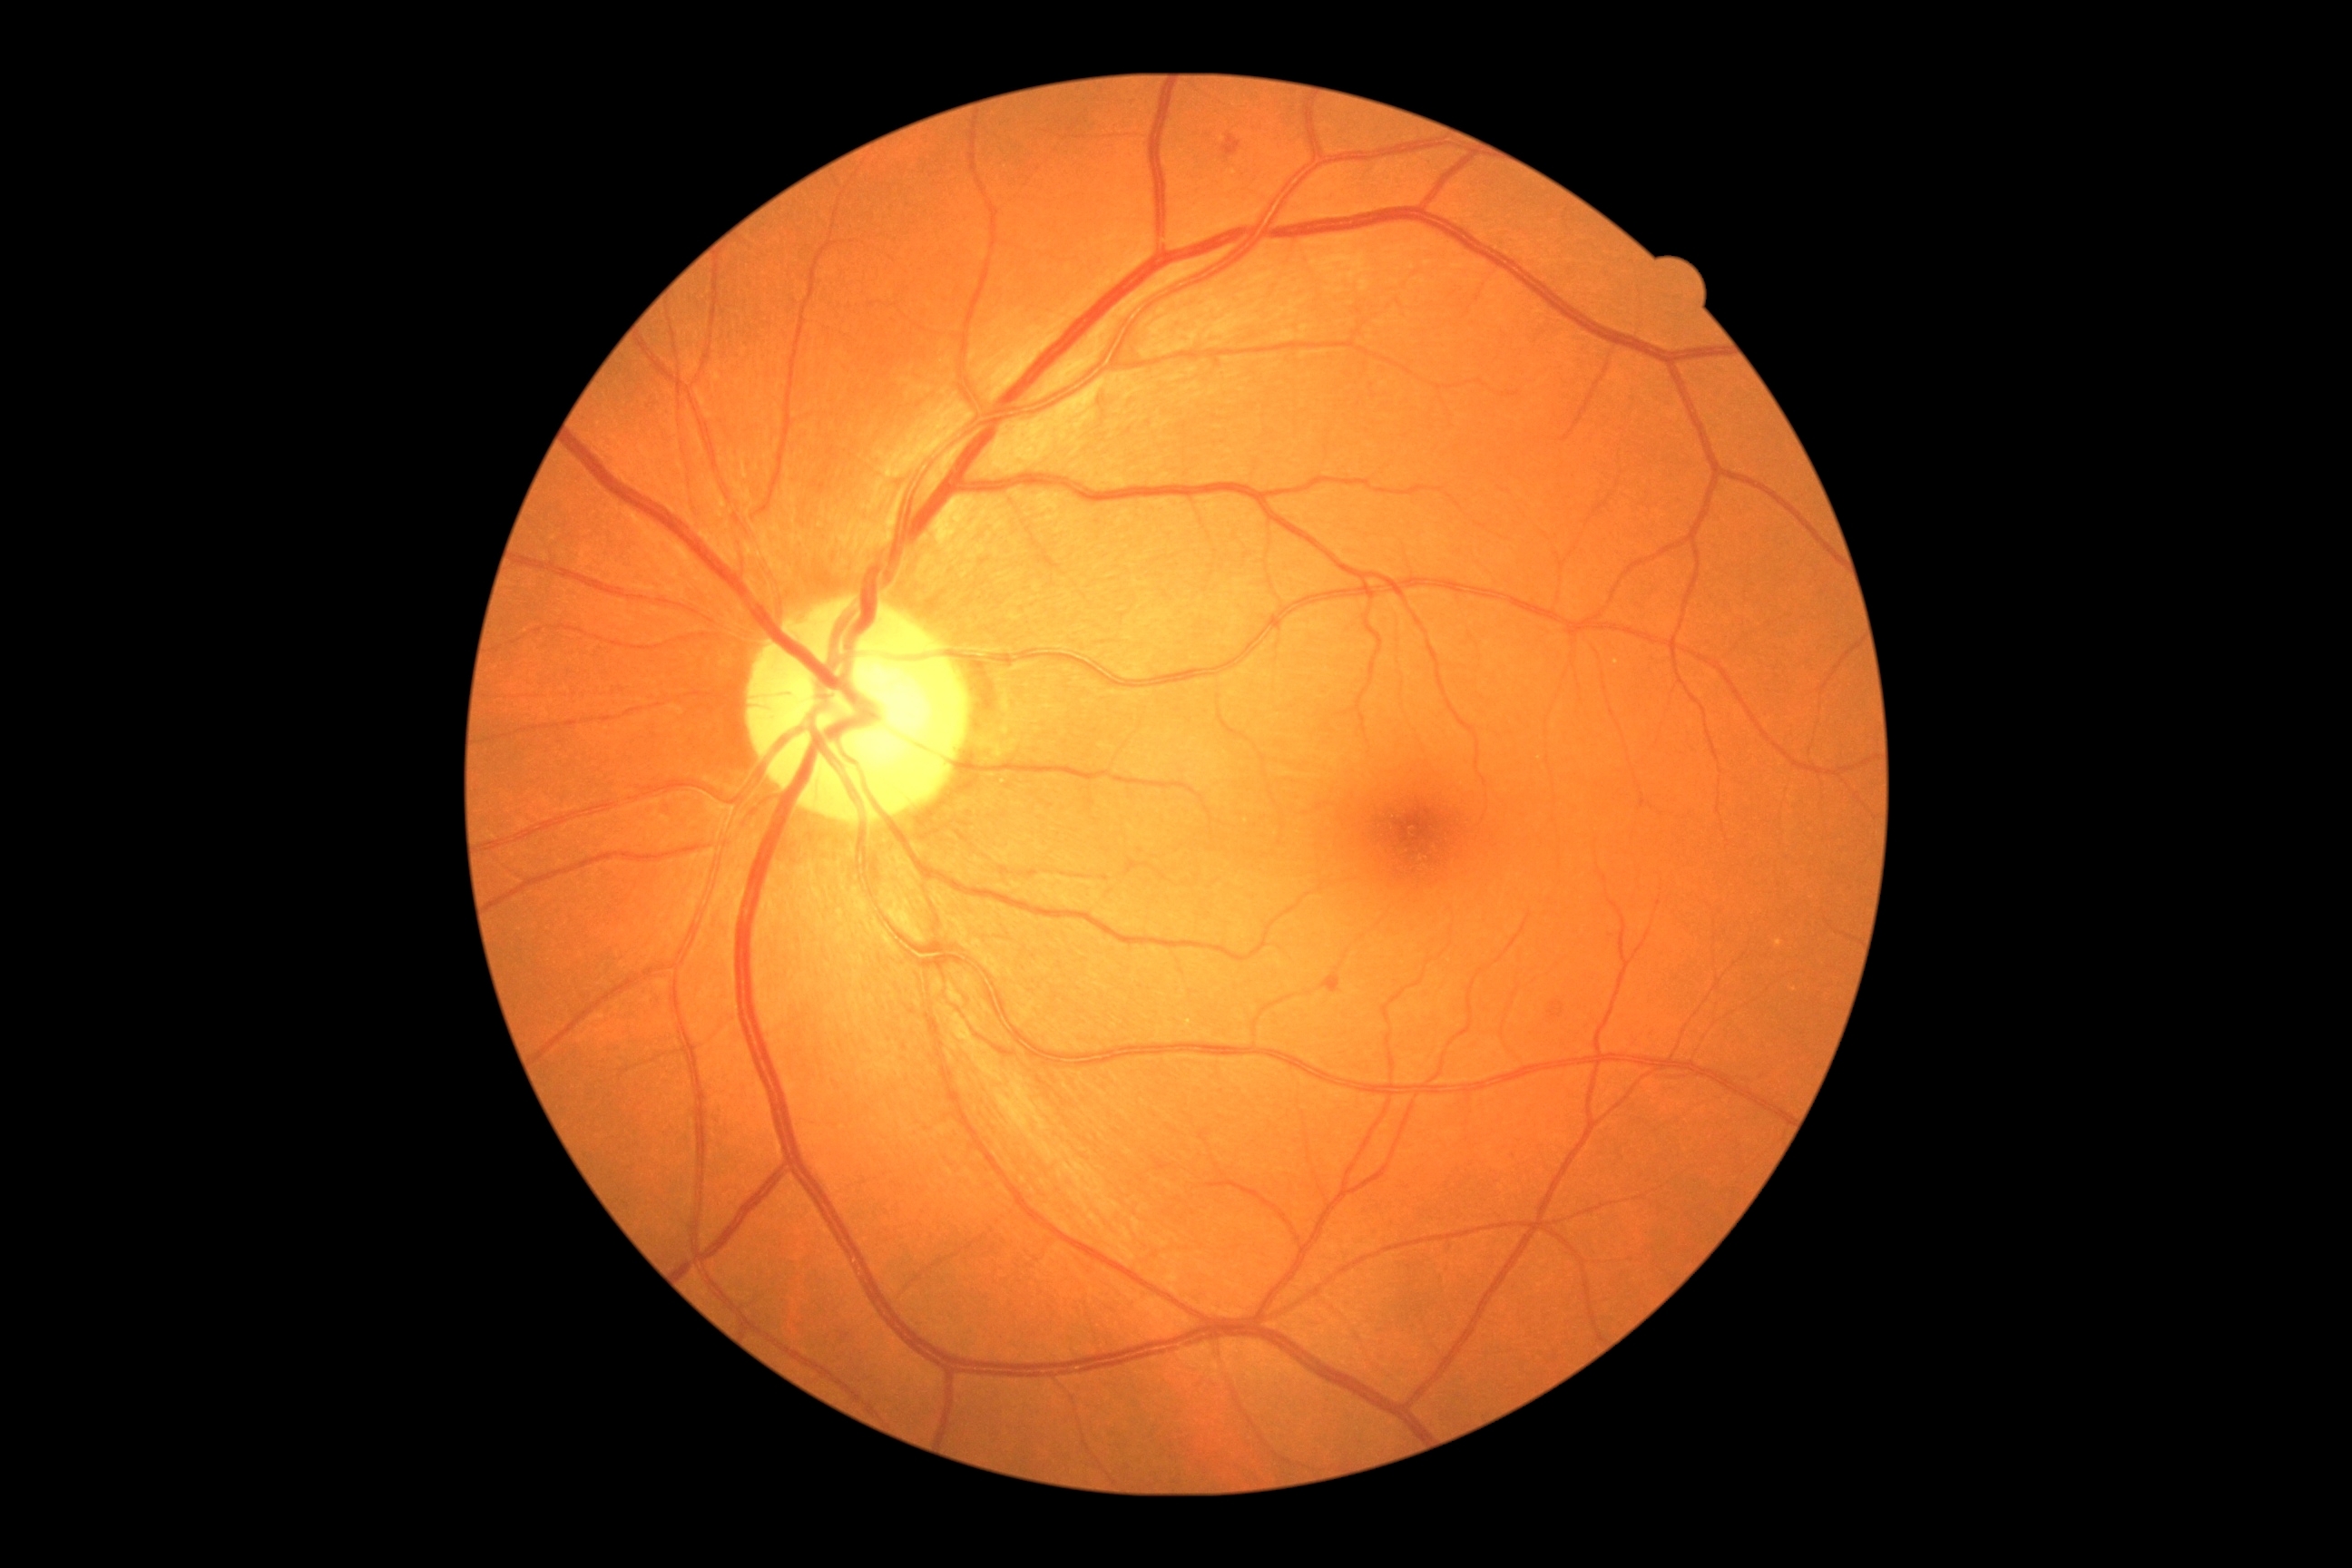
Diabetic retinopathy (DR) is mild NPDR (grade 1)
- soft exudates (SEs): none
- hemorrhages (HEs): none
- microaneurysms (MAs): 1328/977/1338/992; 1226/139/1239/150
- hard exudates (EXs): none